848 by 848 pixels: 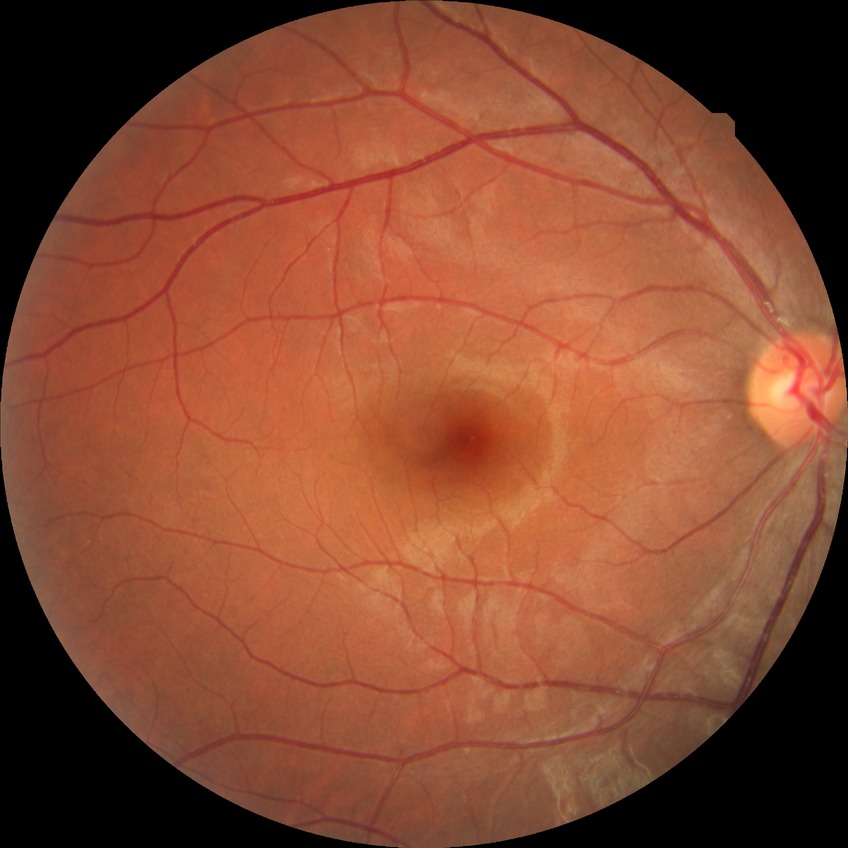

Findings:
– diabetic retinopathy (DR) — NDR (no diabetic retinopathy)